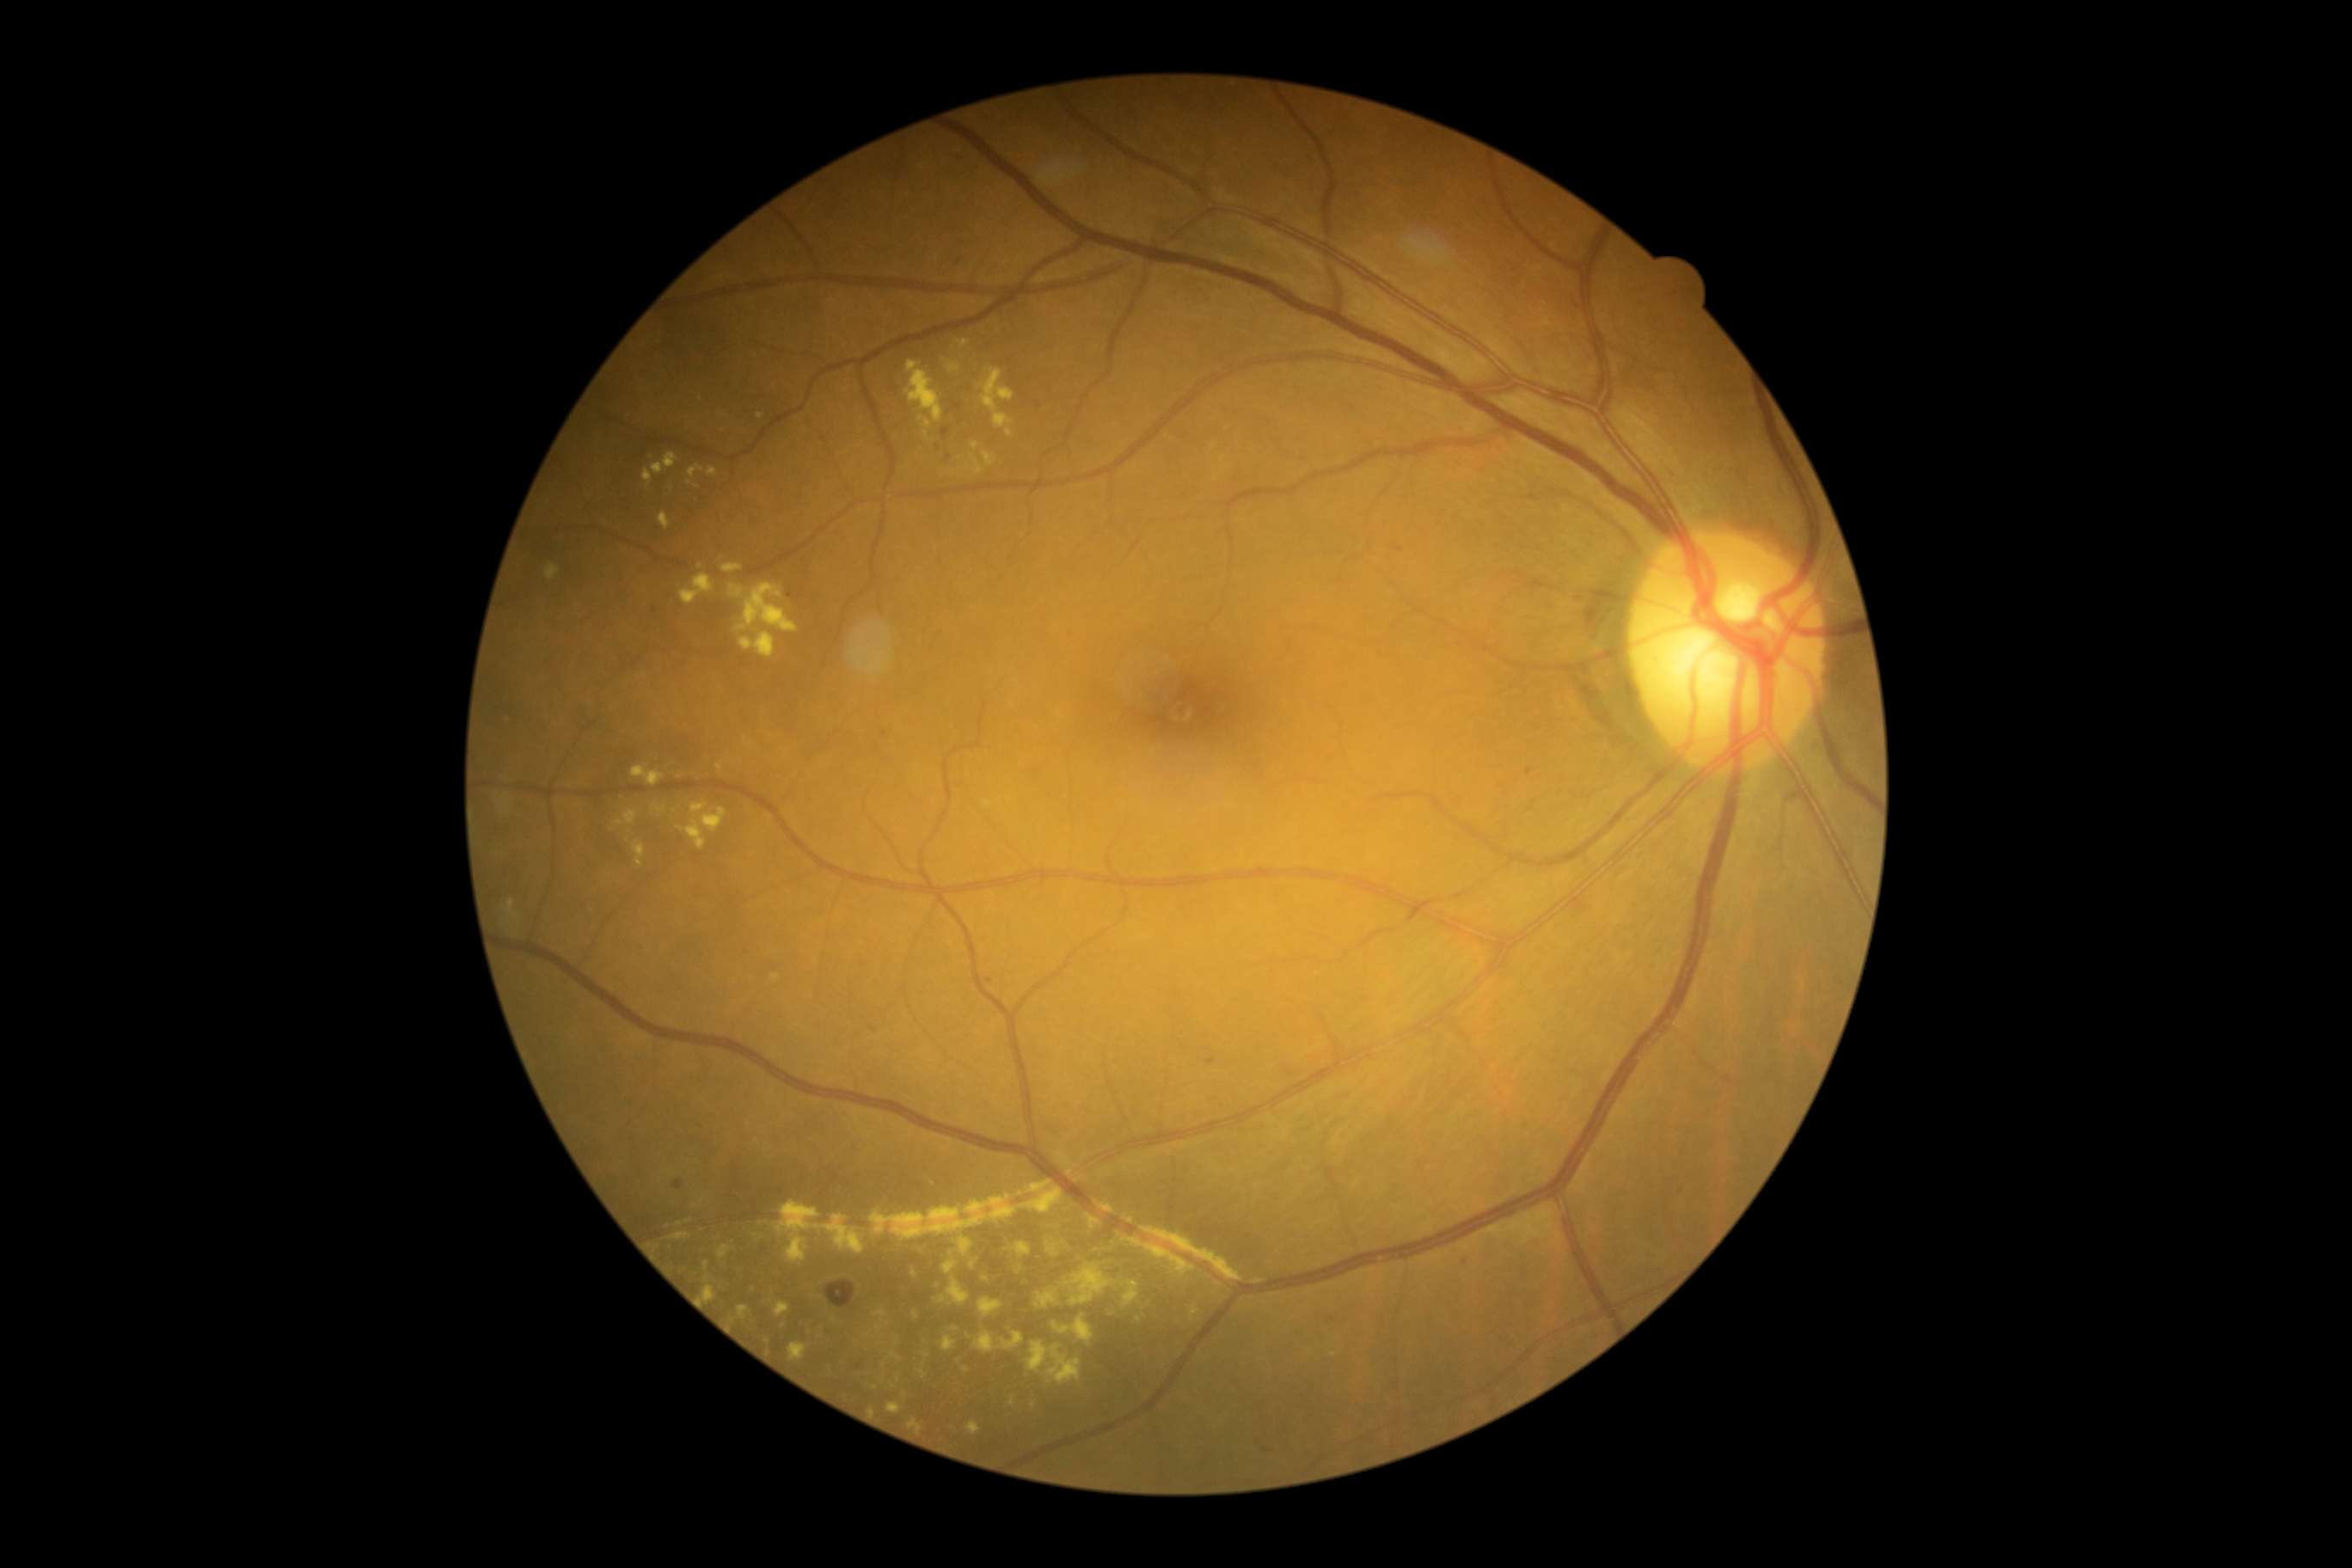
Diabetic retinopathy (DR) is grade 2 (moderate NPDR); non-proliferative diabetic retinopathy.
Microaneurysms (MAs) (partial list) at (left=652, top=606, right=659, bottom=615), (left=874, top=744, right=879, bottom=754), (left=881, top=730, right=888, bottom=738), (left=981, top=976, right=993, bottom=984), (left=1524, top=768, right=1534, bottom=776), (left=787, top=591, right=795, bottom=599), (left=1034, top=401, right=1043, bottom=410), (left=819, top=1326, right=831, bottom=1340), (left=1206, top=1058, right=1218, bottom=1065).
Small MAs near x=874, y=1029, x=1680, y=1190, x=1266, y=1450, x=1465, y=1263, x=1581, y=599, x=938, y=447.
Soft exudates (SEs) are located at (left=1473, top=1206, right=1557, bottom=1242).
Hemorrhages (HEs) are located at (left=1392, top=544, right=1406, bottom=554), (left=1823, top=639, right=1871, bottom=713), (left=1571, top=895, right=1591, bottom=916), (left=826, top=1280, right=857, bottom=1309), (left=673, top=1179, right=685, bottom=1189), (left=941, top=427, right=950, bottom=441), (left=946, top=453, right=952, bottom=462).
Hard exudates (EXs) (partial list) at (left=738, top=1306, right=749, bottom=1320), (left=869, top=1180, right=1065, bottom=1240), (left=668, top=1232, right=690, bottom=1240), (left=912, top=1311, right=919, bottom=1320), (left=1096, top=1201, right=1115, bottom=1215), (left=721, top=563, right=744, bottom=573), (left=905, top=362, right=943, bottom=424), (left=1034, top=1289, right=1060, bottom=1309), (left=1005, top=429, right=1014, bottom=438), (left=680, top=575, right=714, bottom=606), (left=957, top=340, right=969, bottom=348), (left=874, top=1309, right=890, bottom=1332).
Small EXs near x=690, y=1221, x=750, y=747, x=680, y=777, x=1096, y=1251, x=760, y=416, x=938, y=1285, x=926, y=1354.